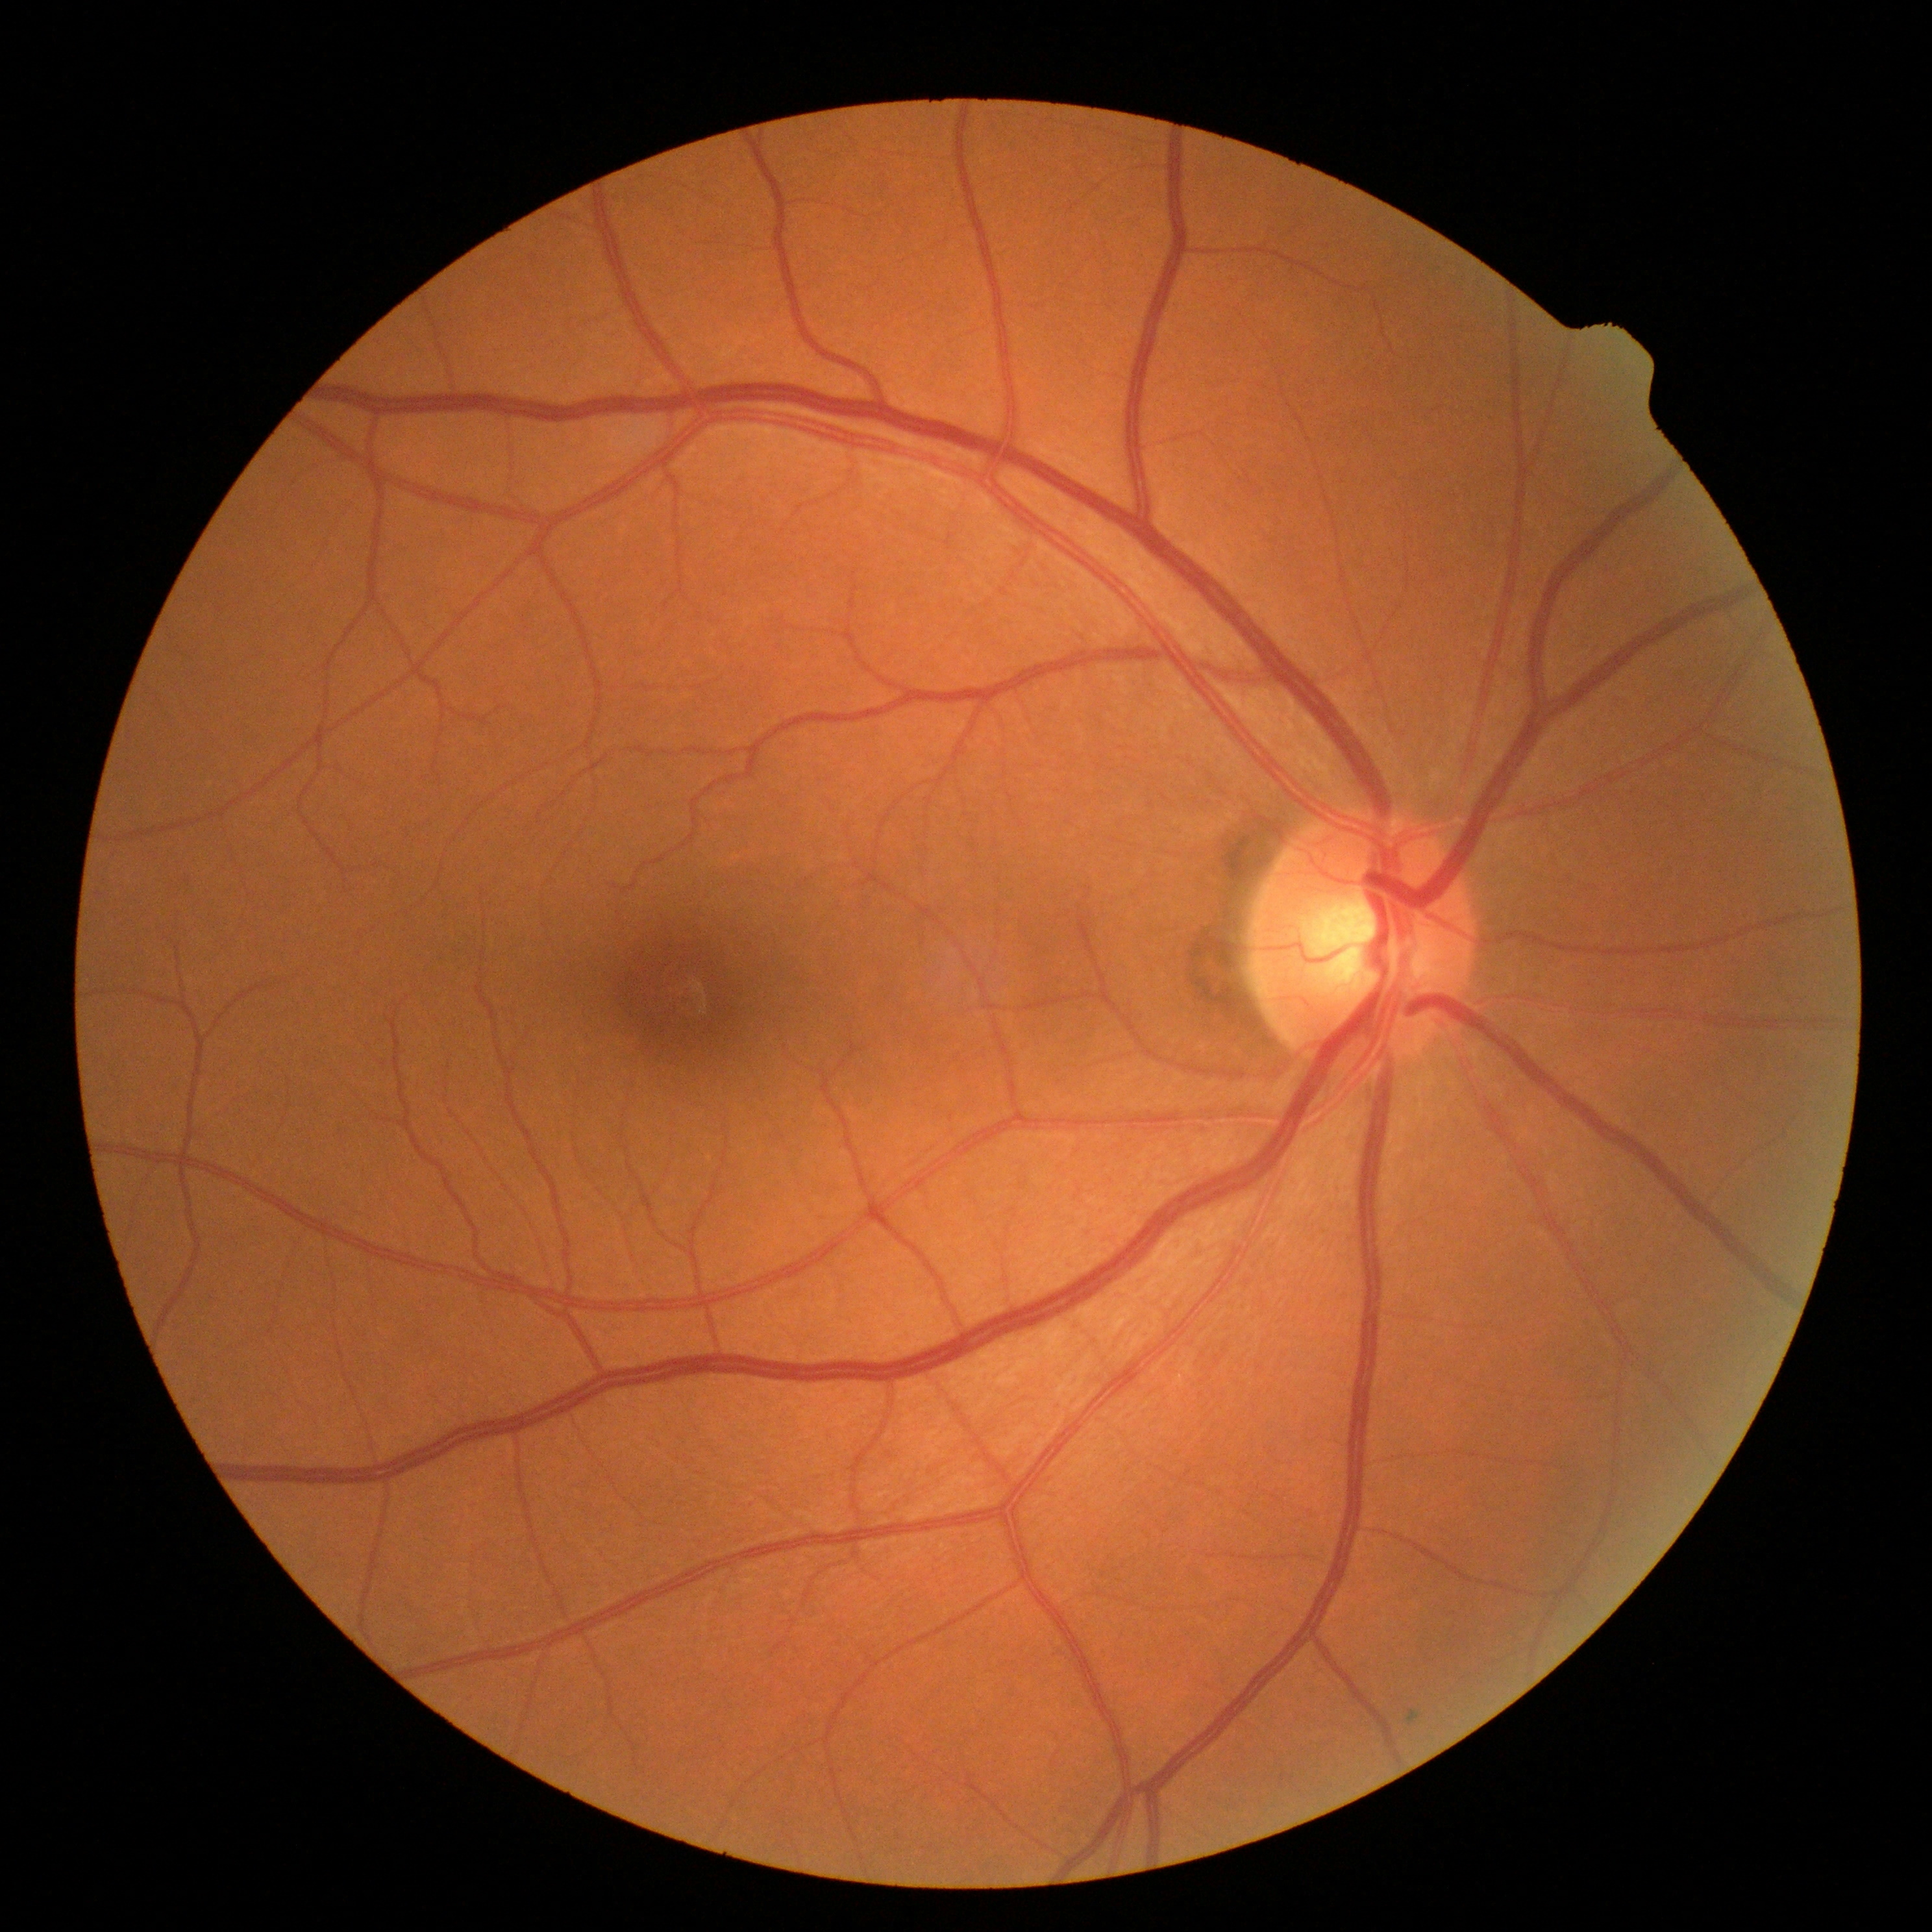 diabetic retinopathy grade=no apparent diabetic retinopathy (0).